Portable fundus camera image; FOV: 60 degrees
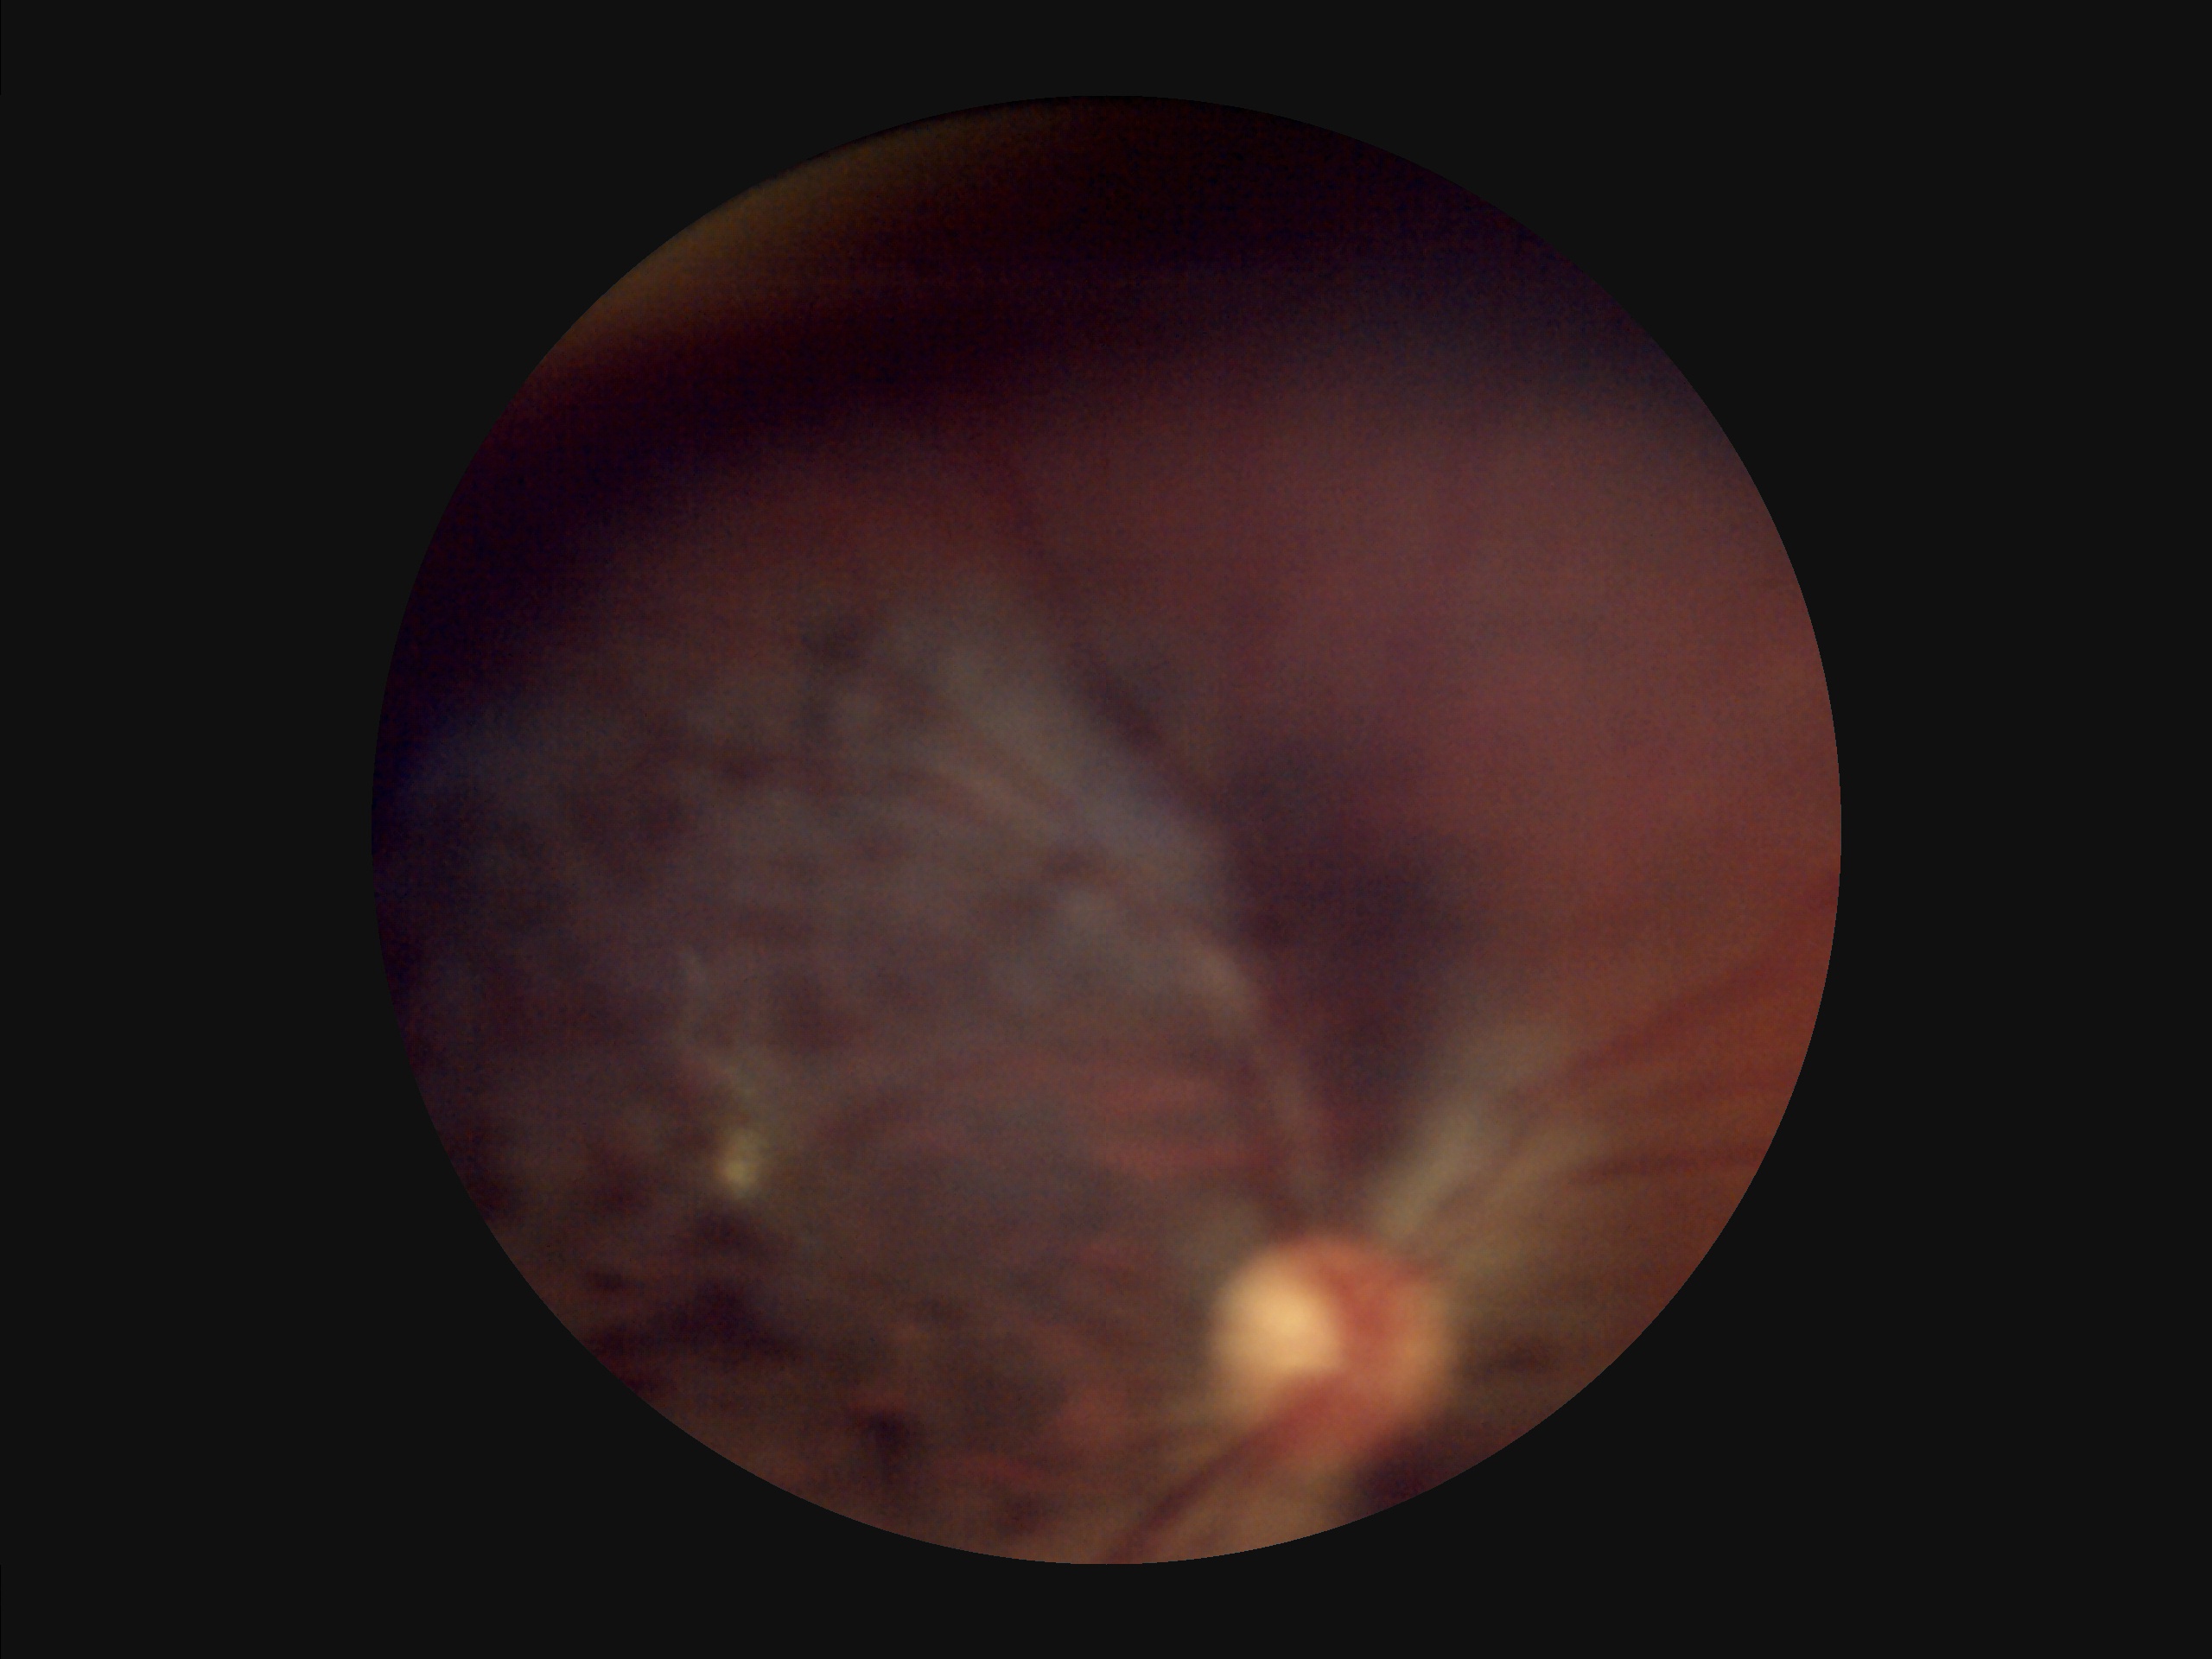
Overall quality is poor; the image is difficult to grade. The image is blurry. Illumination is uneven. Vessels and details are hard to distinguish.